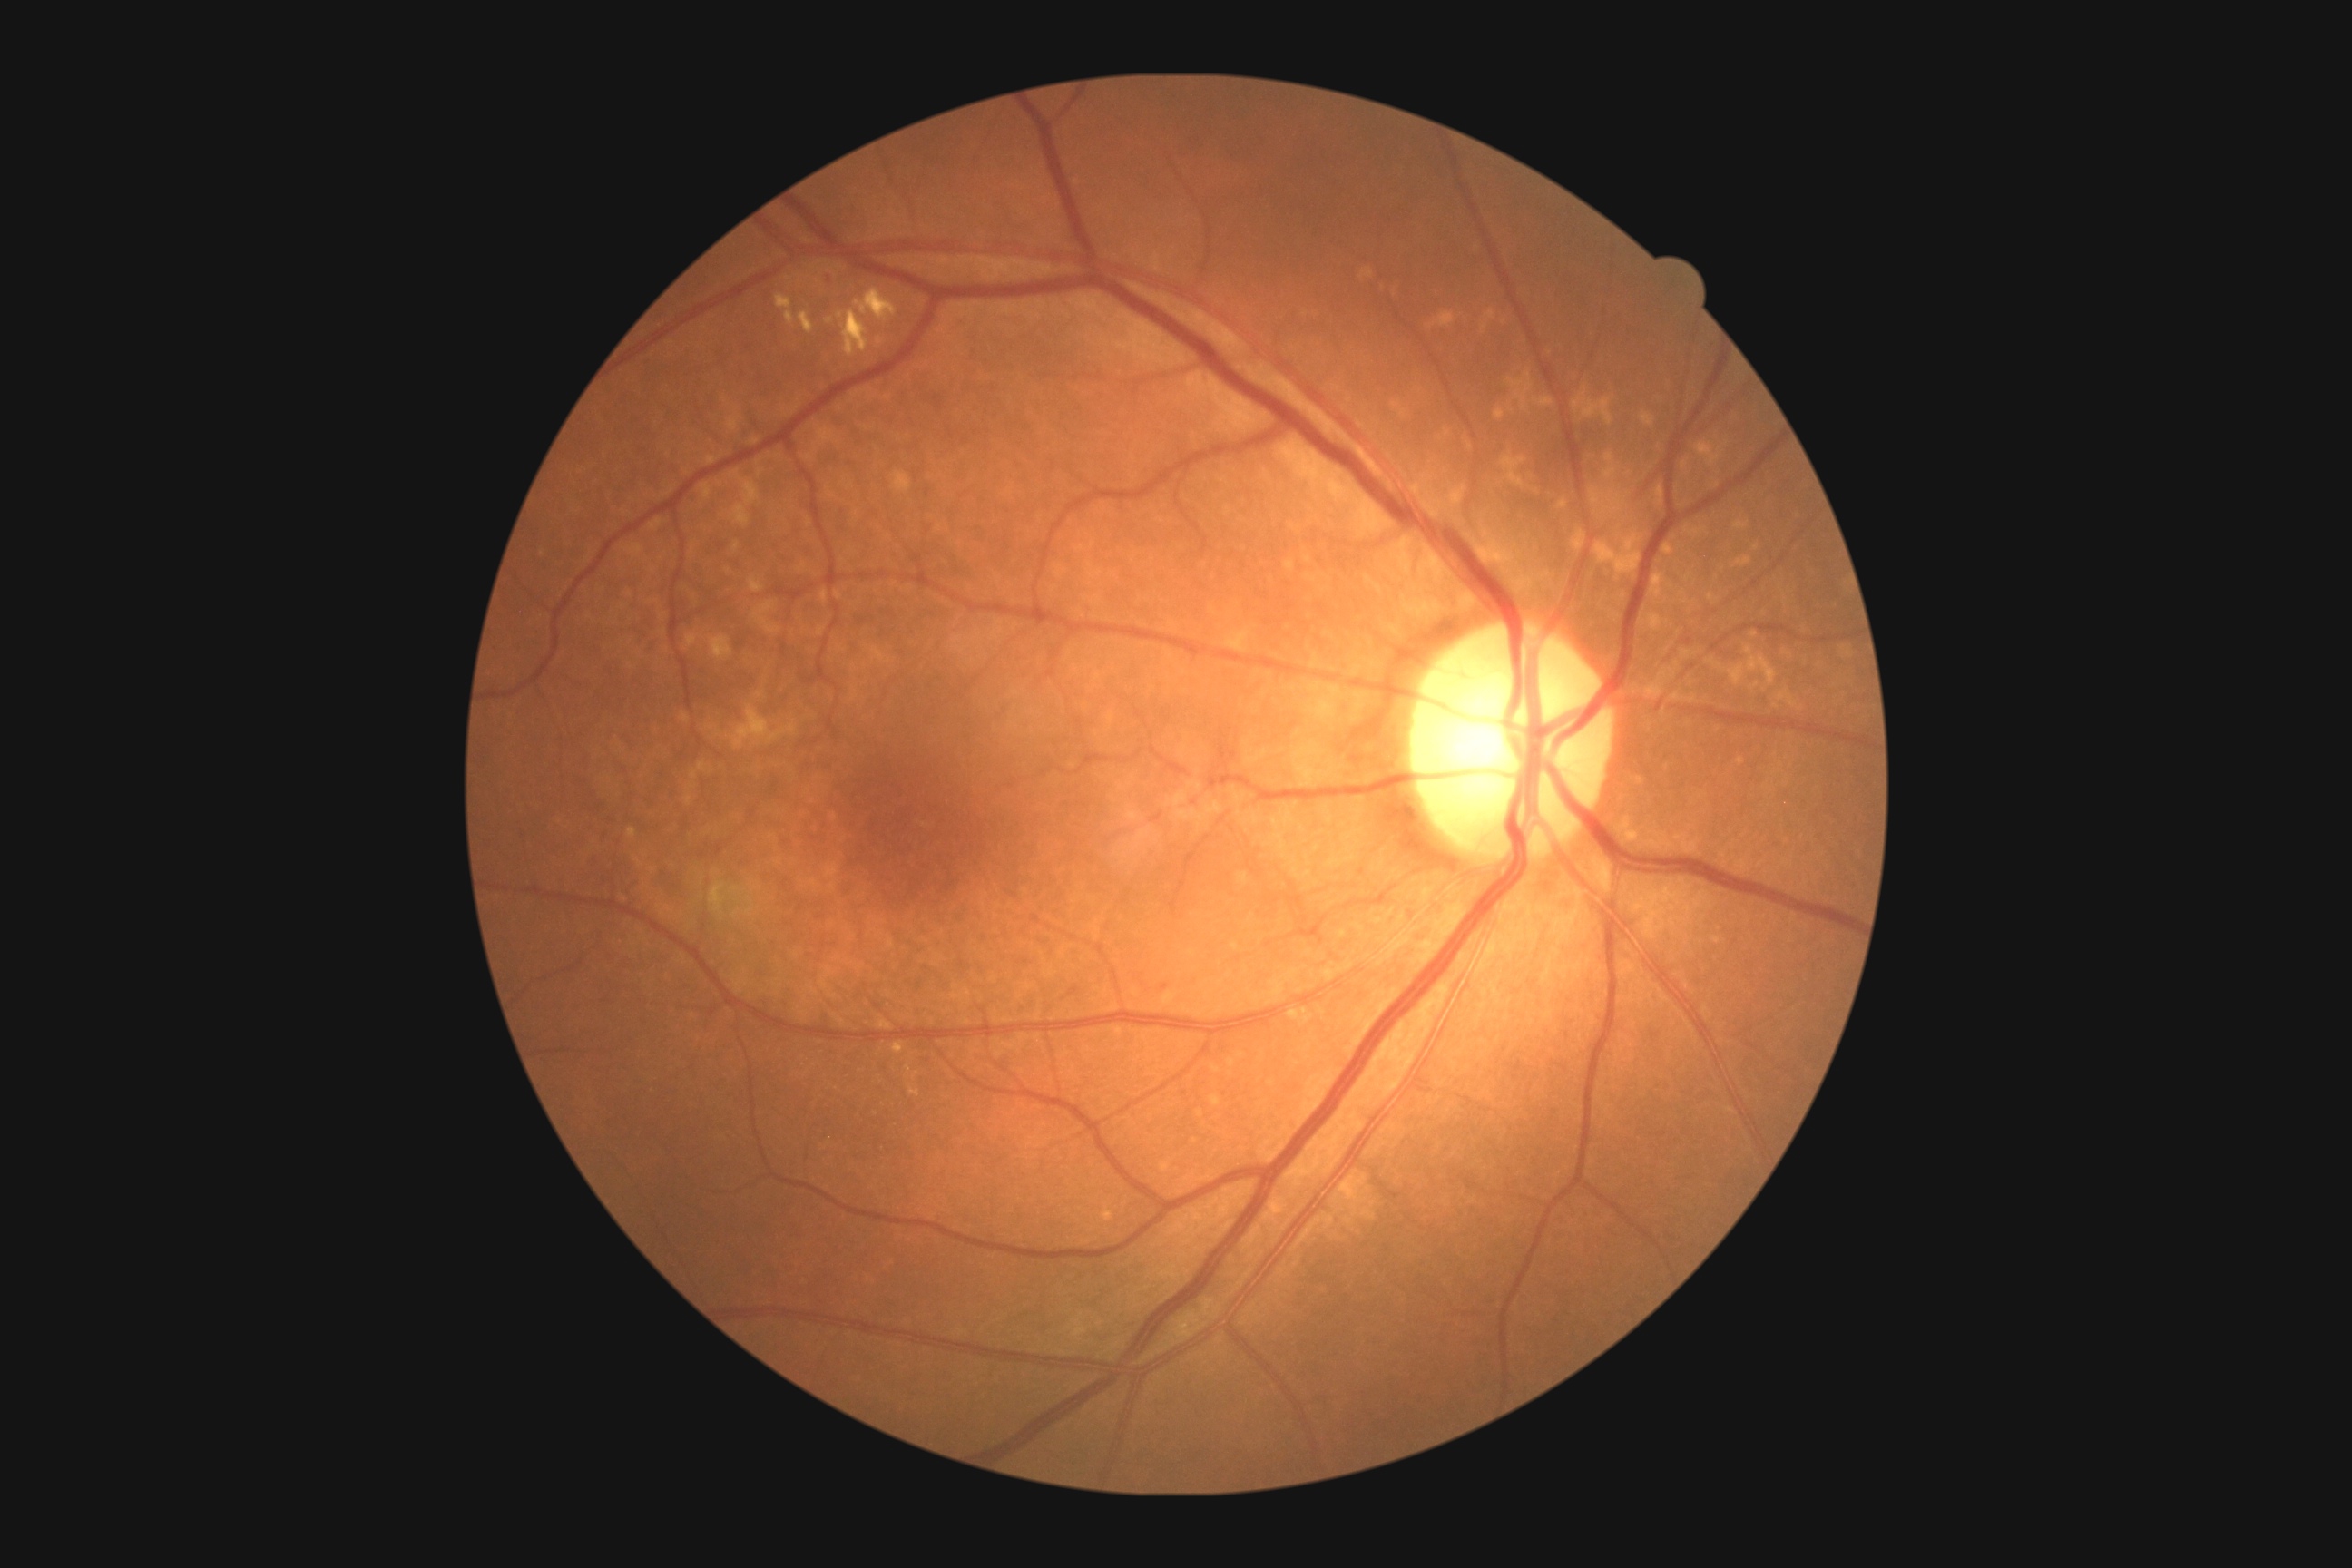

Diabetic retinopathy severity is 2/4 — more than just microaneurysms but less than severe NPDR.